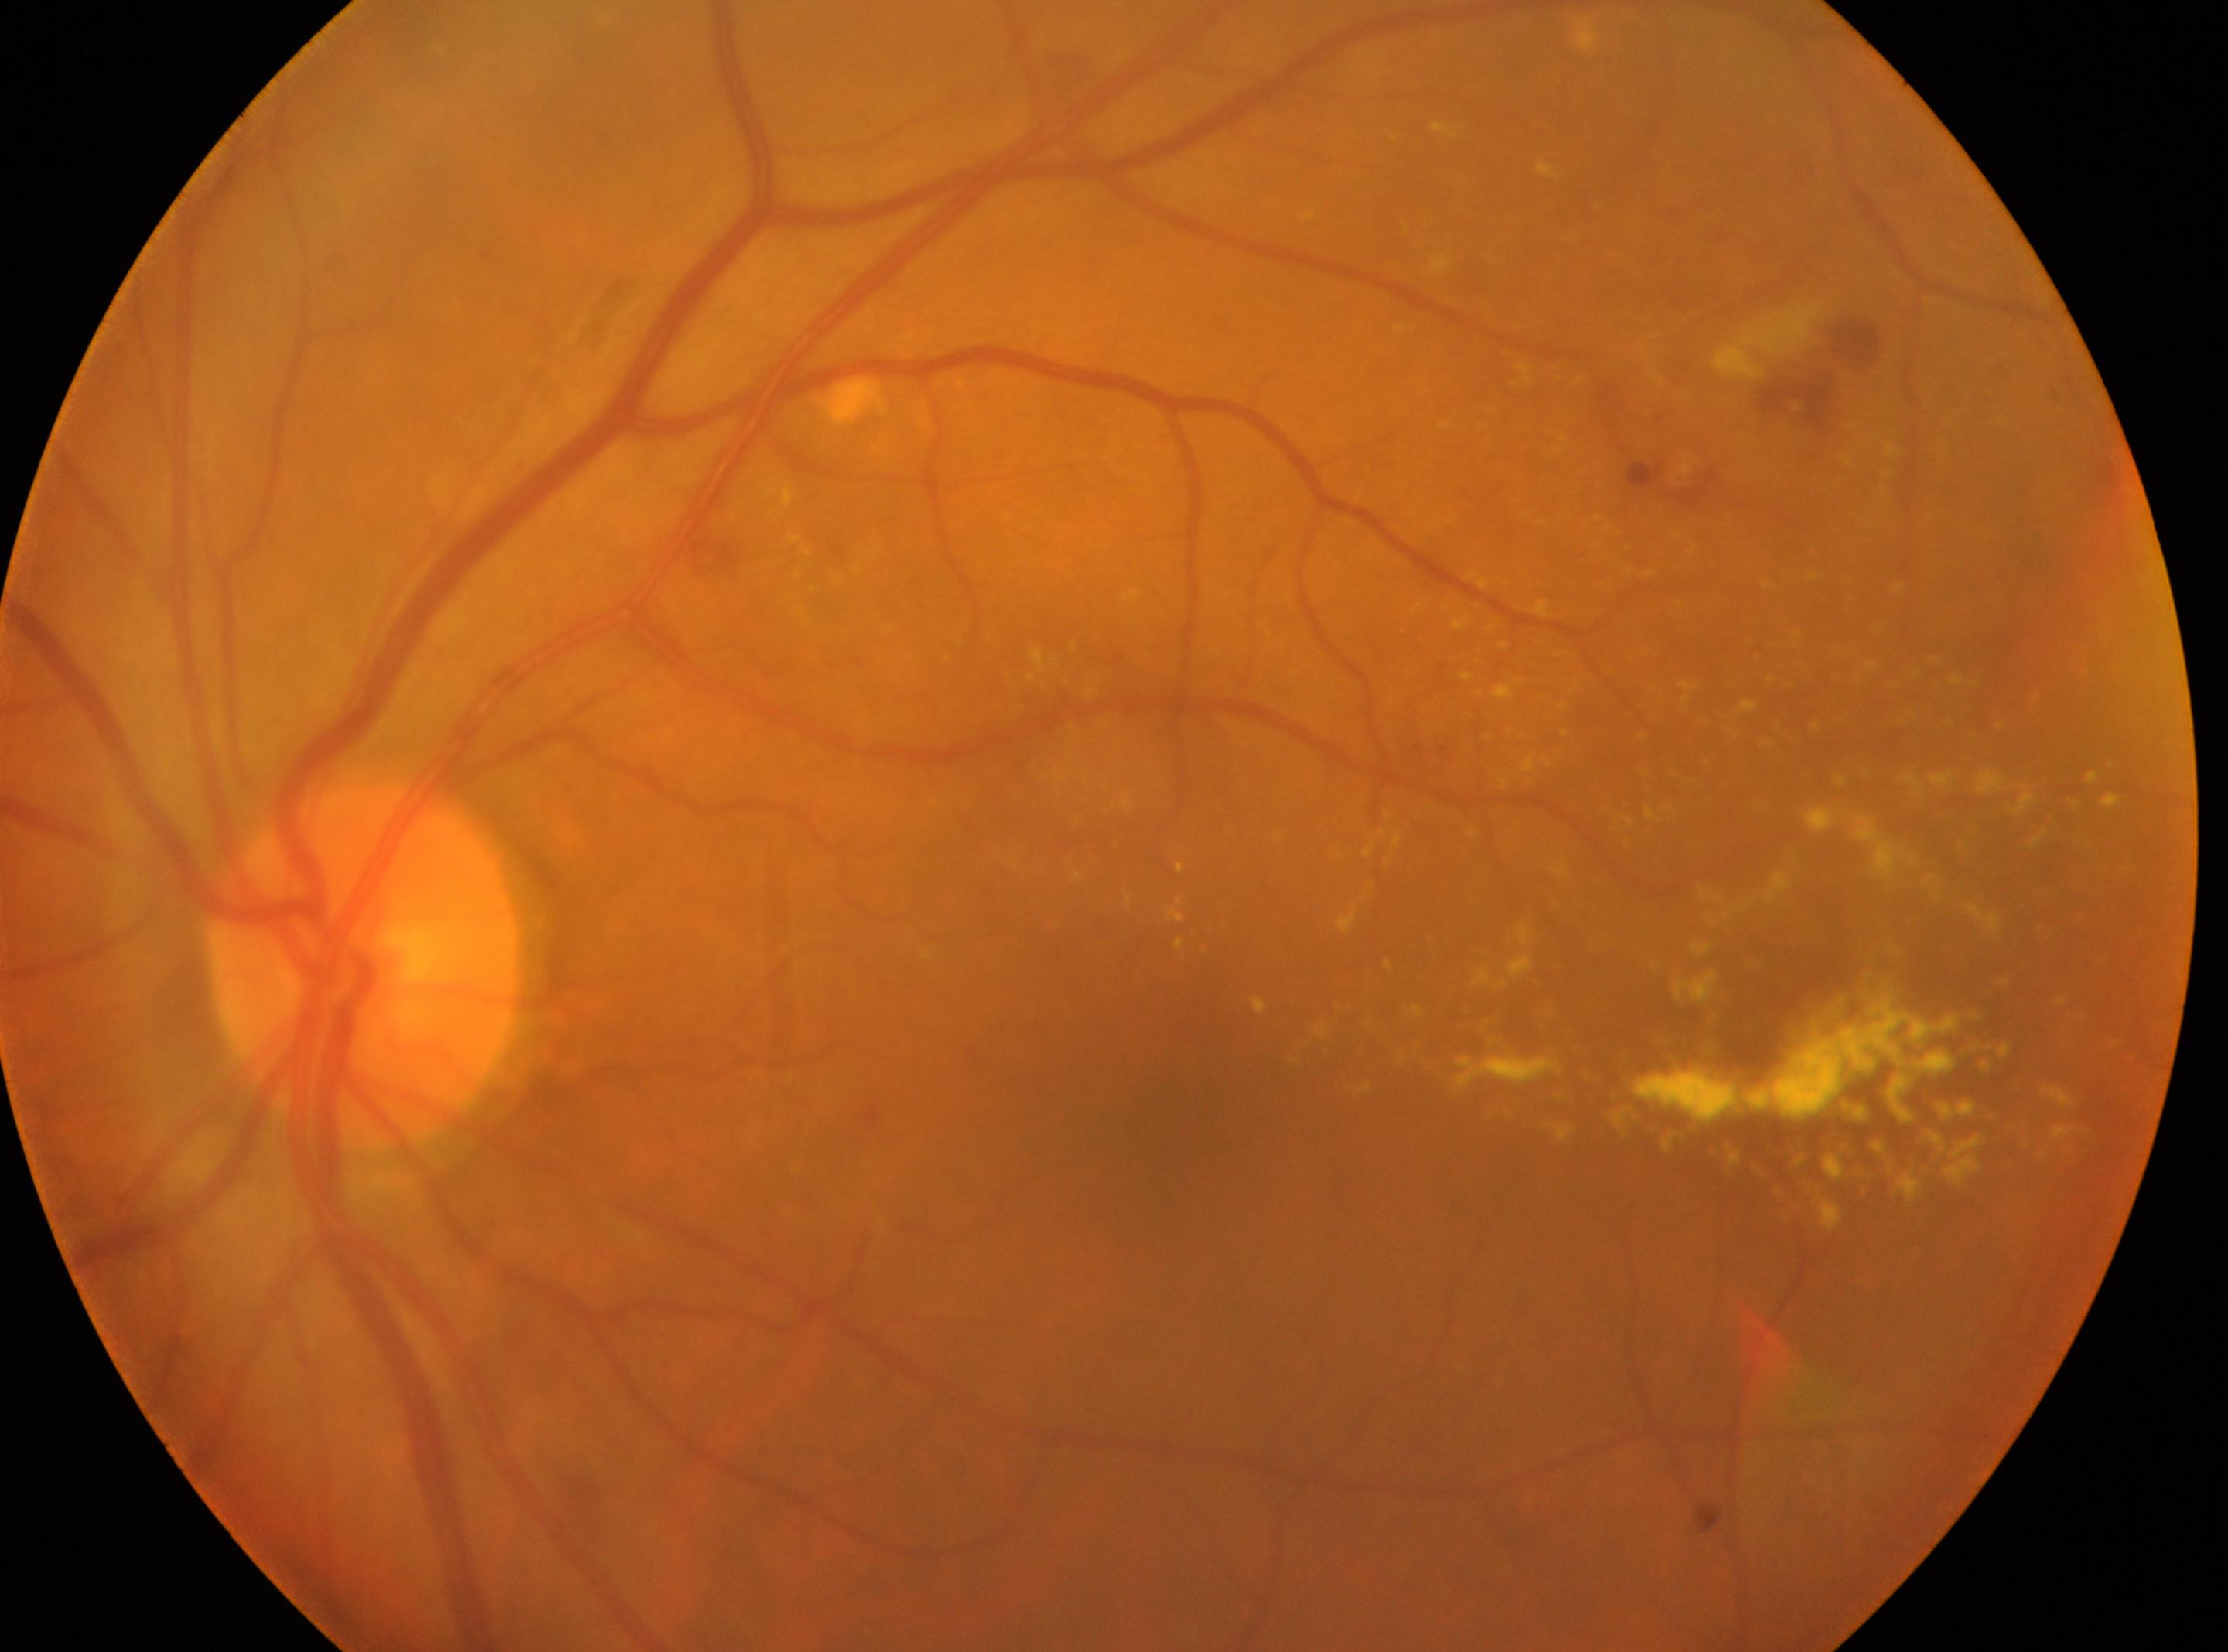

DR: grade 2 — more than just microaneurysms but less than severe NPDR. Optic disc: (x: 362, y: 967). Fovea: (x: 1179, y: 1128). Eye: the left eye.